No pharmacologic dilation · acquired with a NIDEK AFC-230 · image size 848x848 · color fundus image.
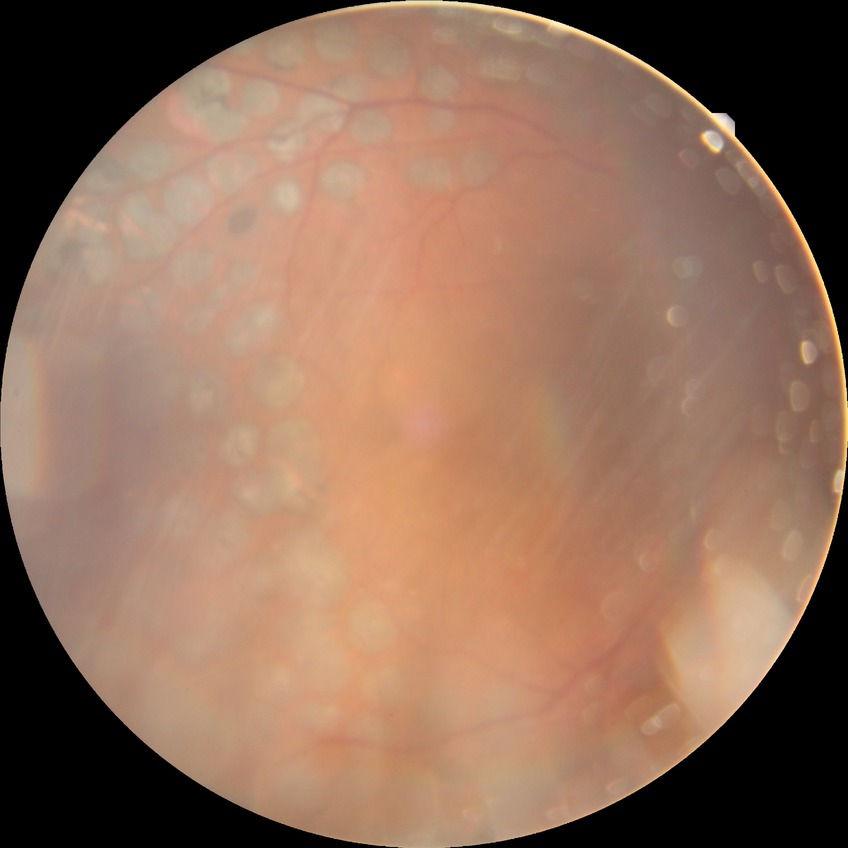 Diabetic retinopathy (DR): proliferative diabetic retinopathy (PDR).